FOV: 45 degrees, color fundus image:
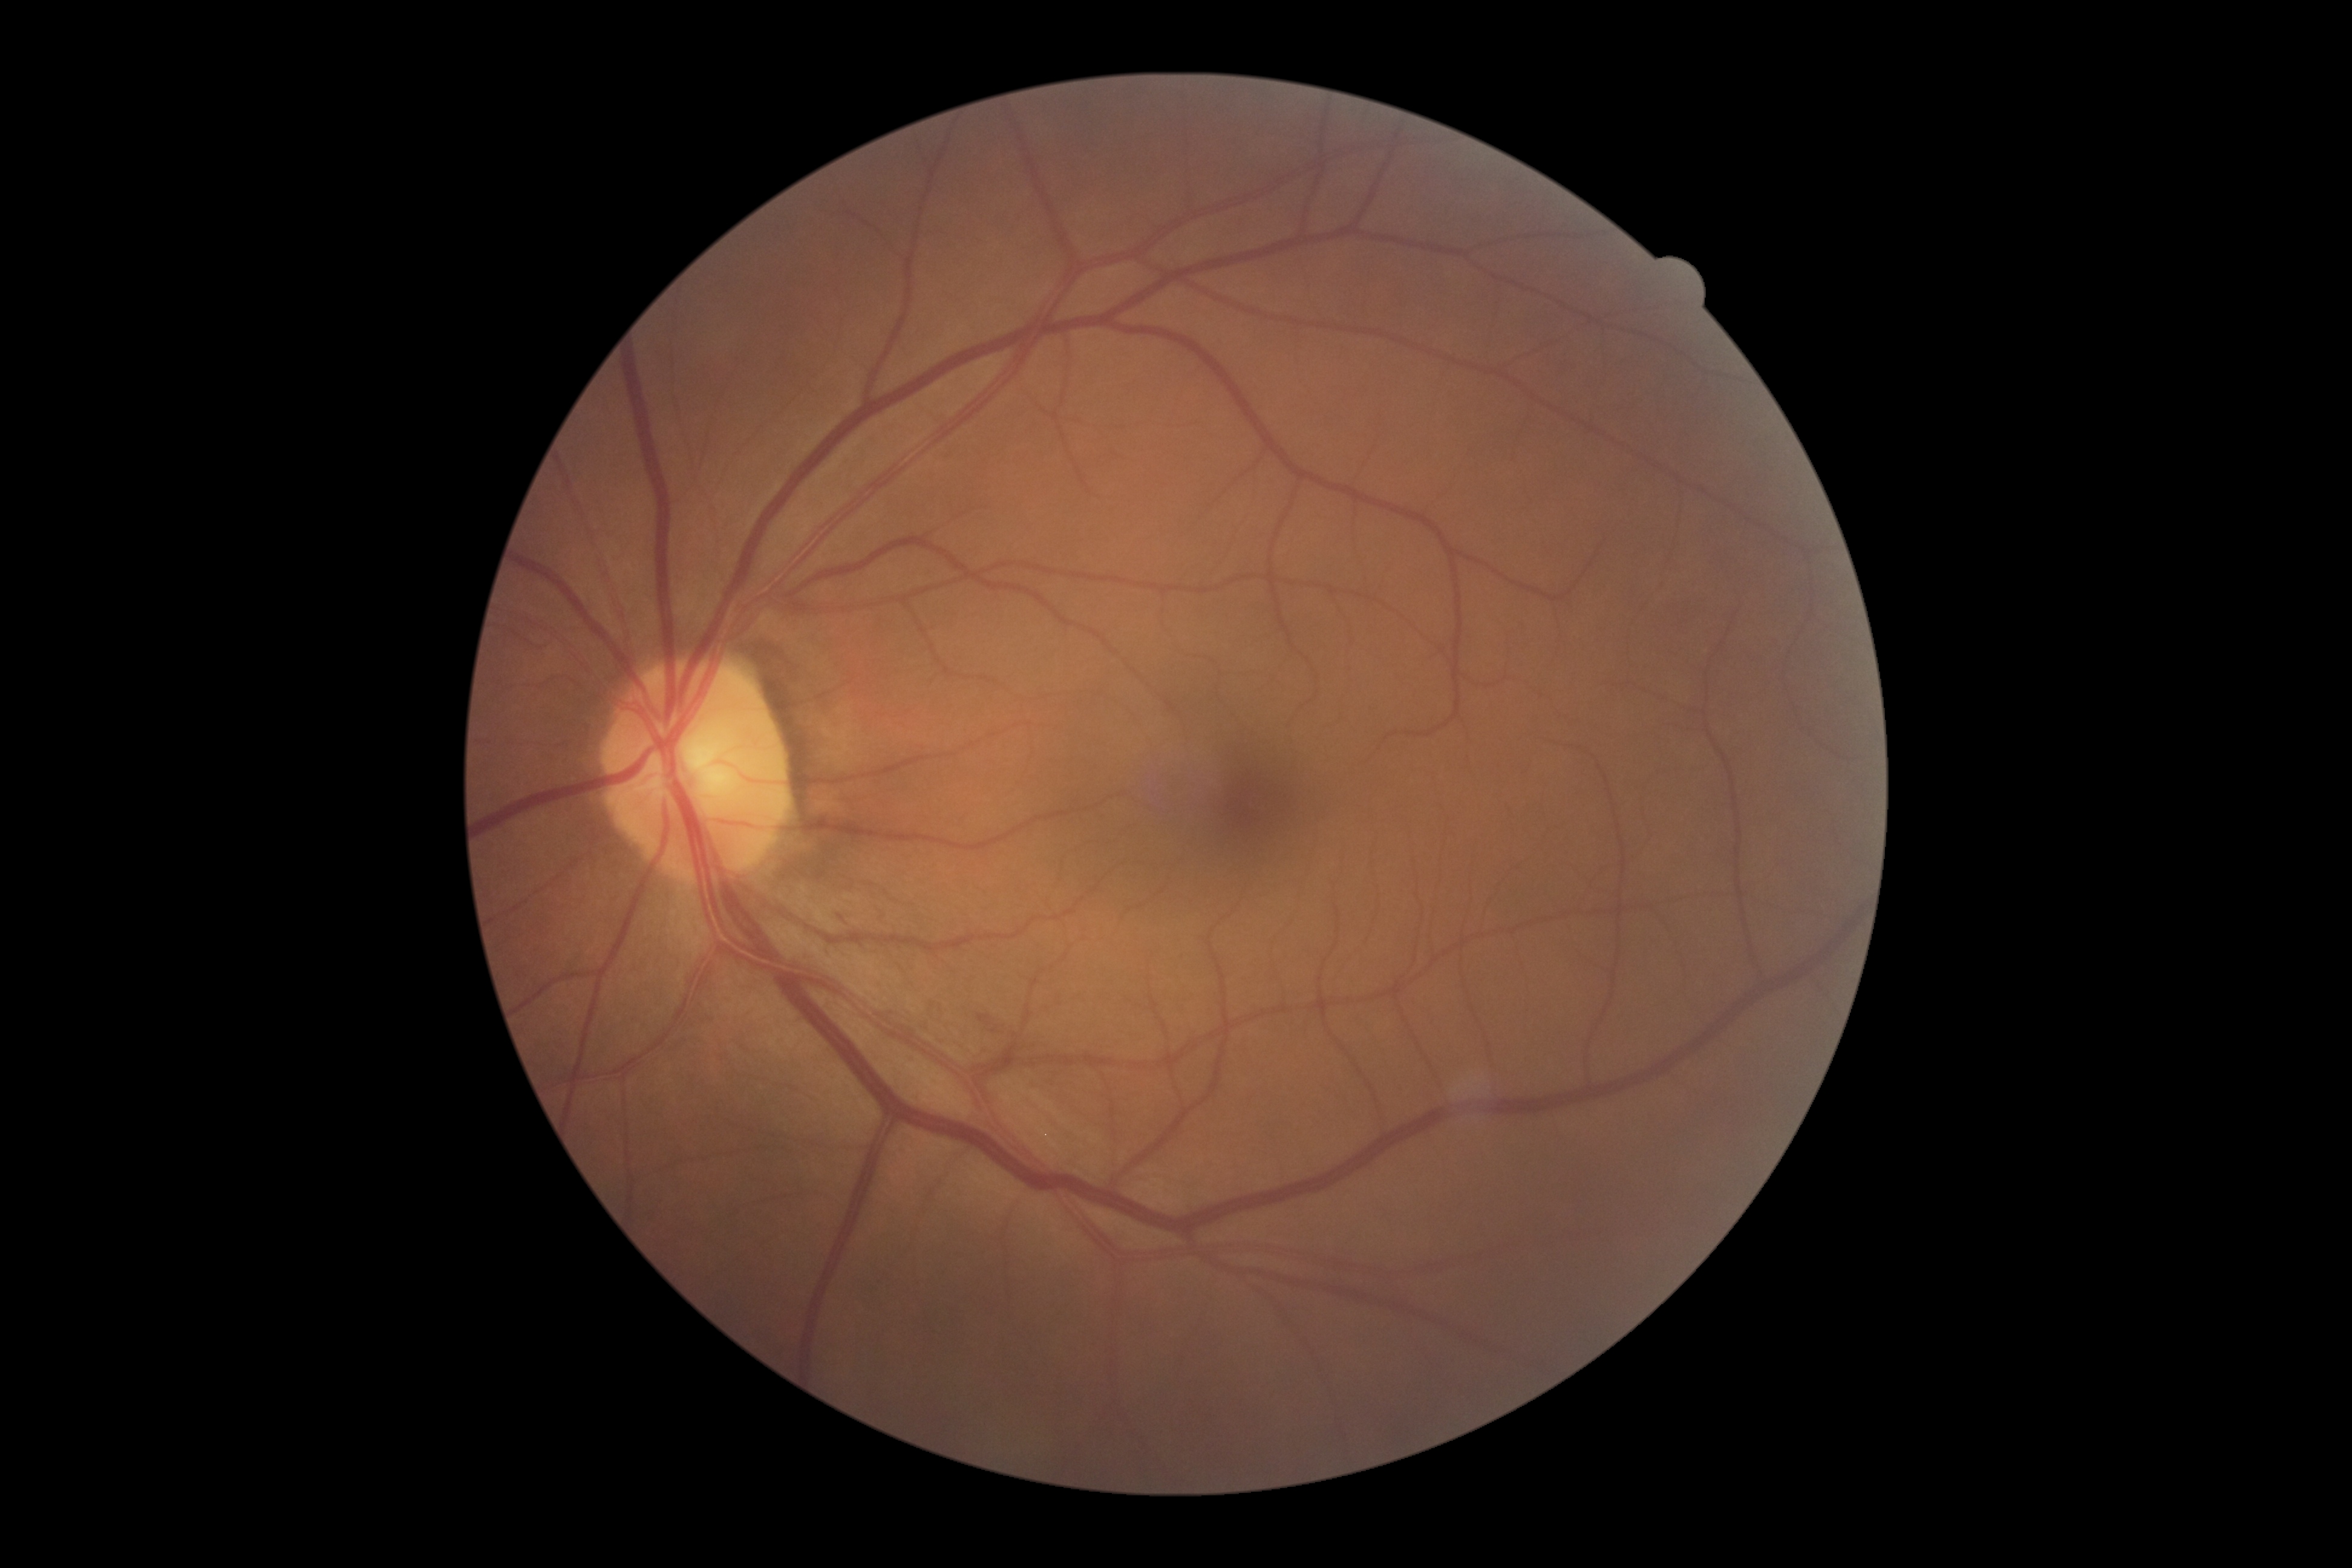

DR is 0 — no visible signs of diabetic retinopathy.